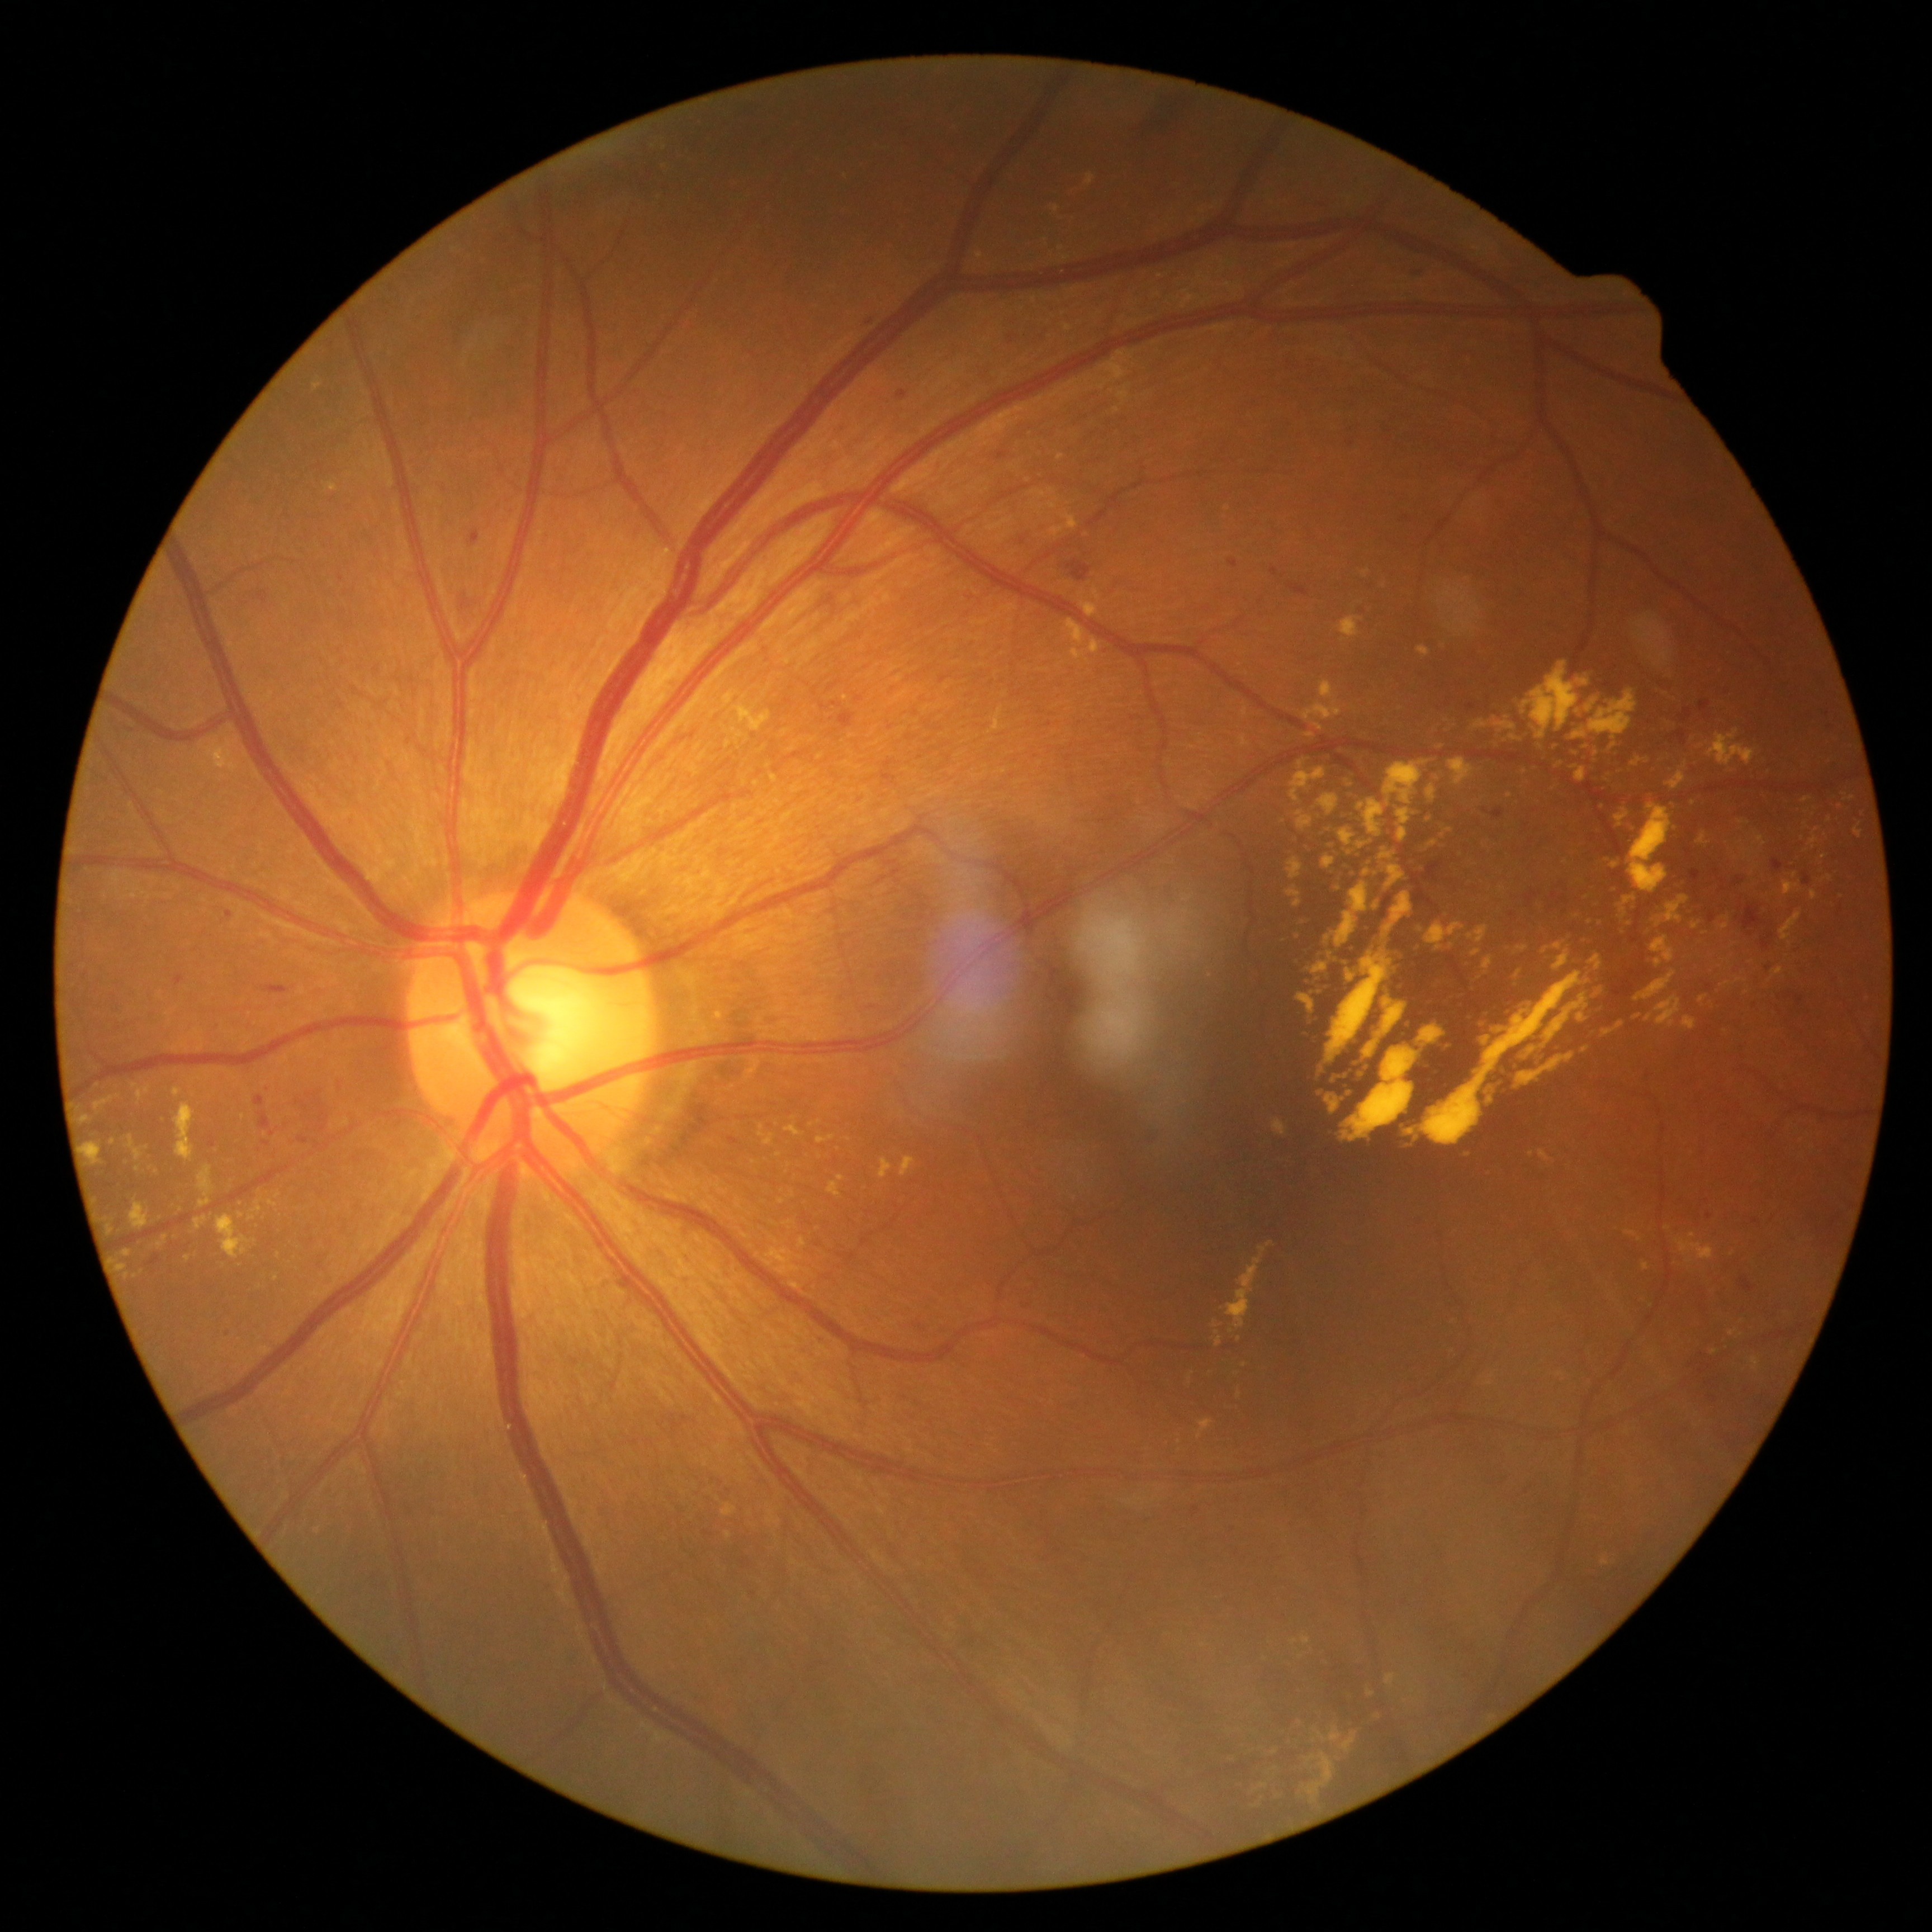
Diabetic retinopathy (DR): 2/4 — more than just microaneurysms but less than severe NPDR. Disease class: non-proliferative diabetic retinopathy.